Posterior pole photograph
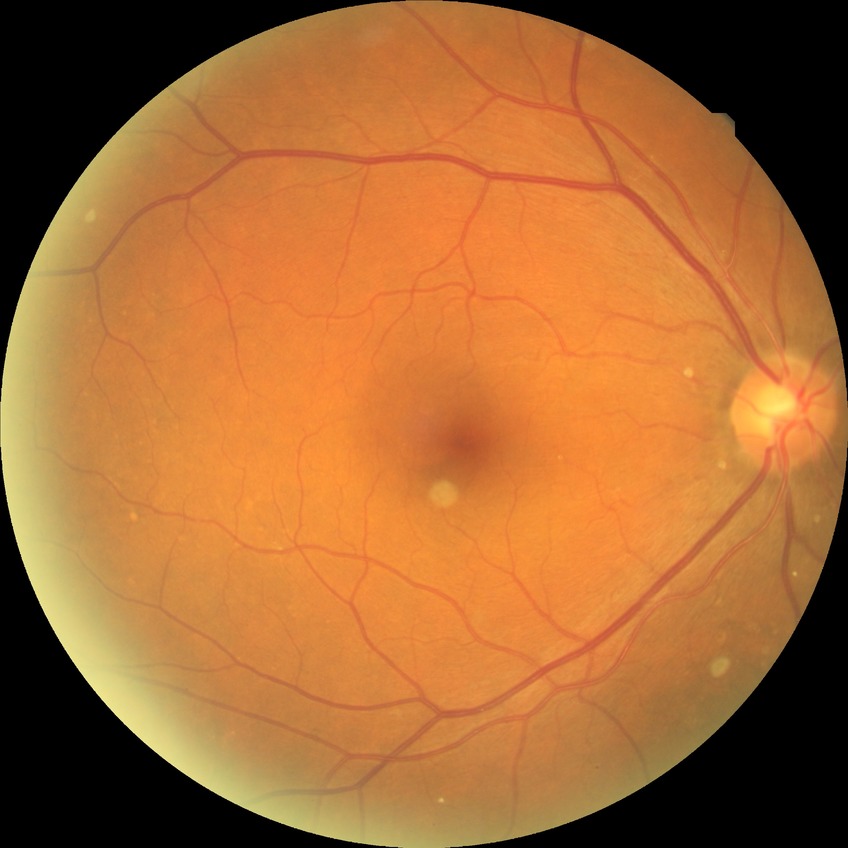
Davis grade: NDR, DR impression: negative for DR.